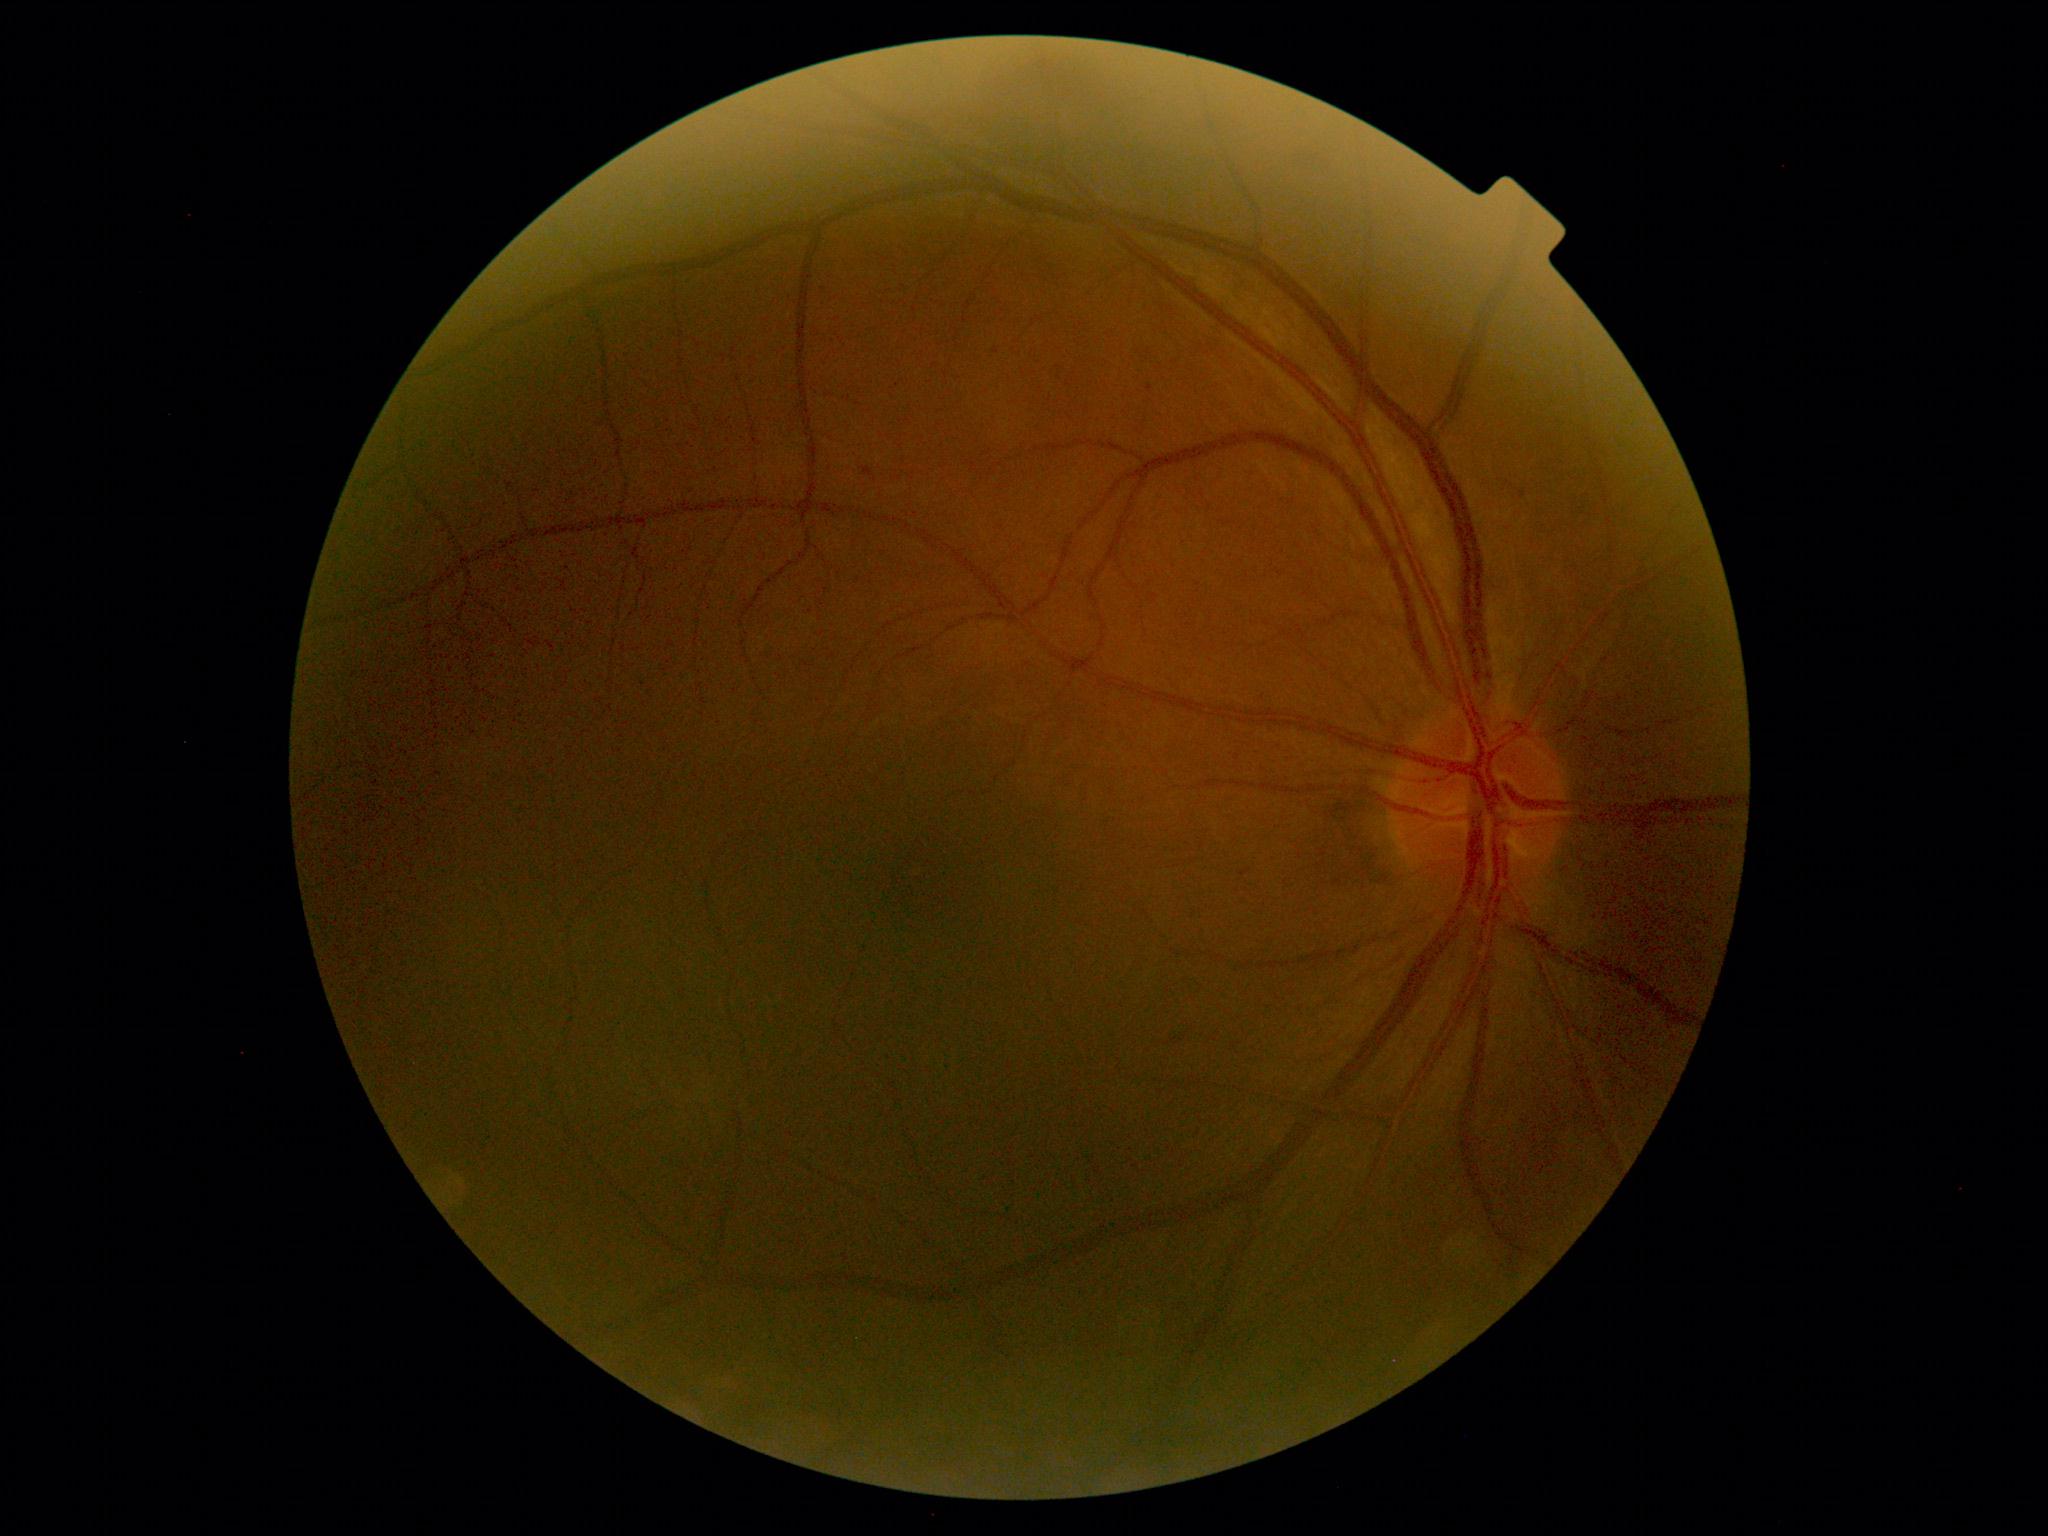

• retinopathy — mild non-proliferative diabetic retinopathy (grade 1)